Davis DR grading, 45-degree field of view — 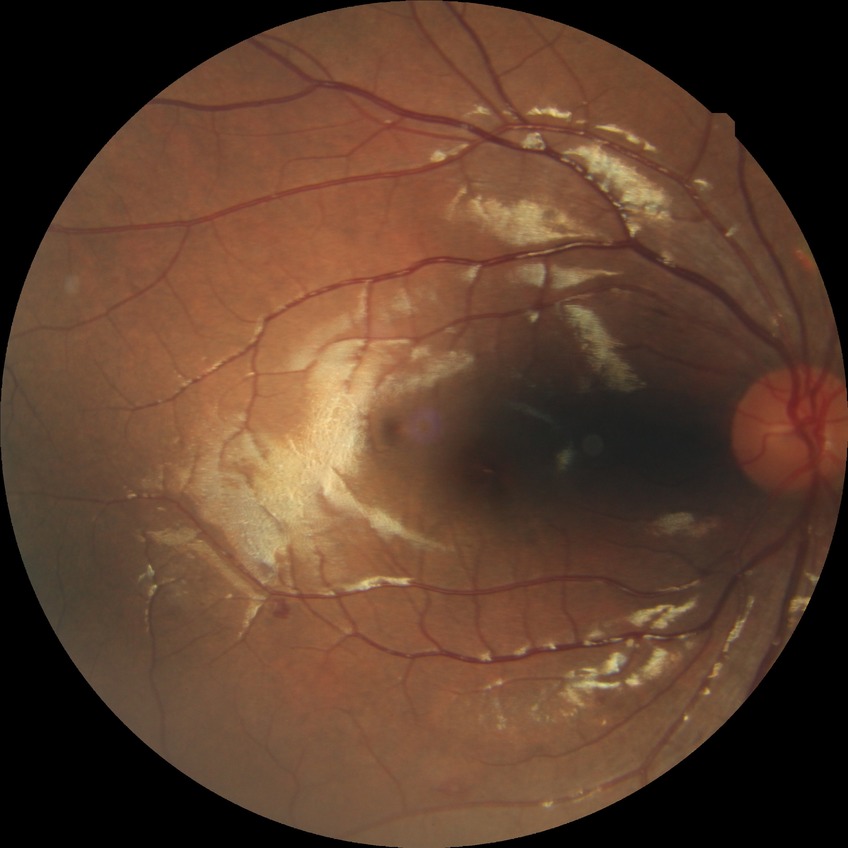 davis_grade: SDR (simple diabetic retinopathy)
proliferative_class: non-proliferative diabetic retinopathy